45-degree field of view:
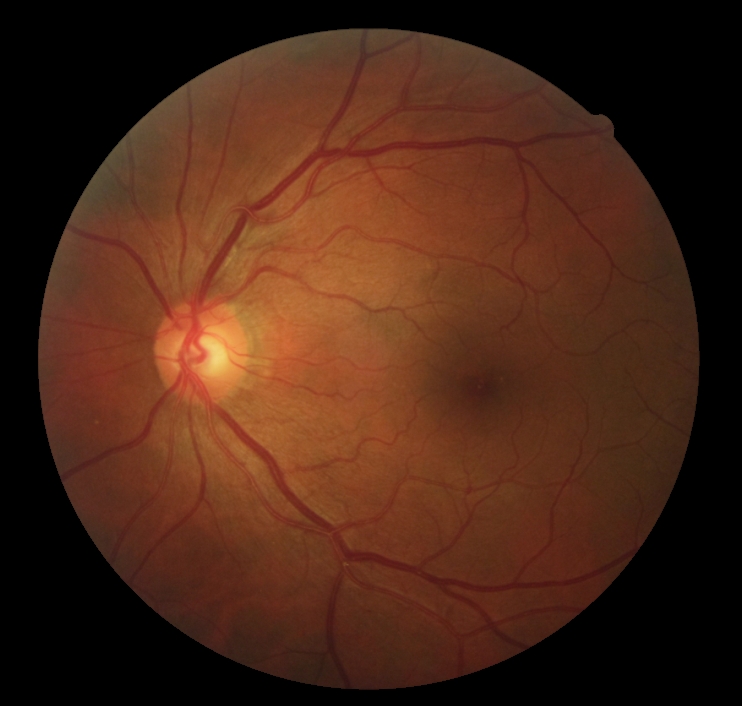

retinopathy=no apparent retinopathy (grade 0).